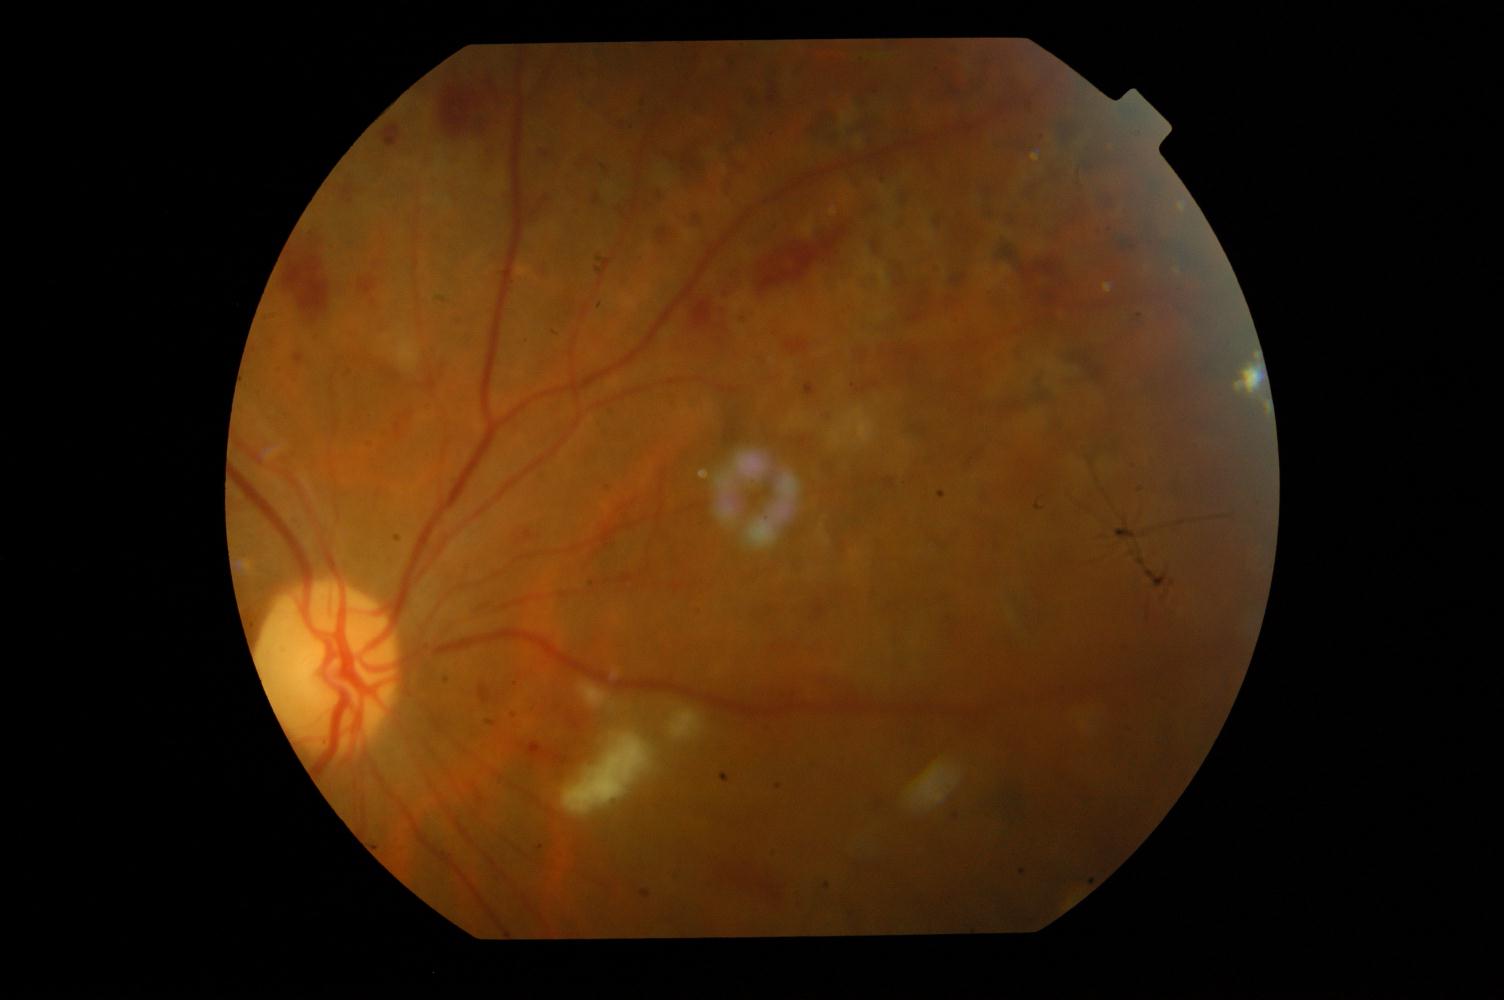

Impression: diabetic retinopathy.